Diabetic retinopathy graded by the modified Davis classification.
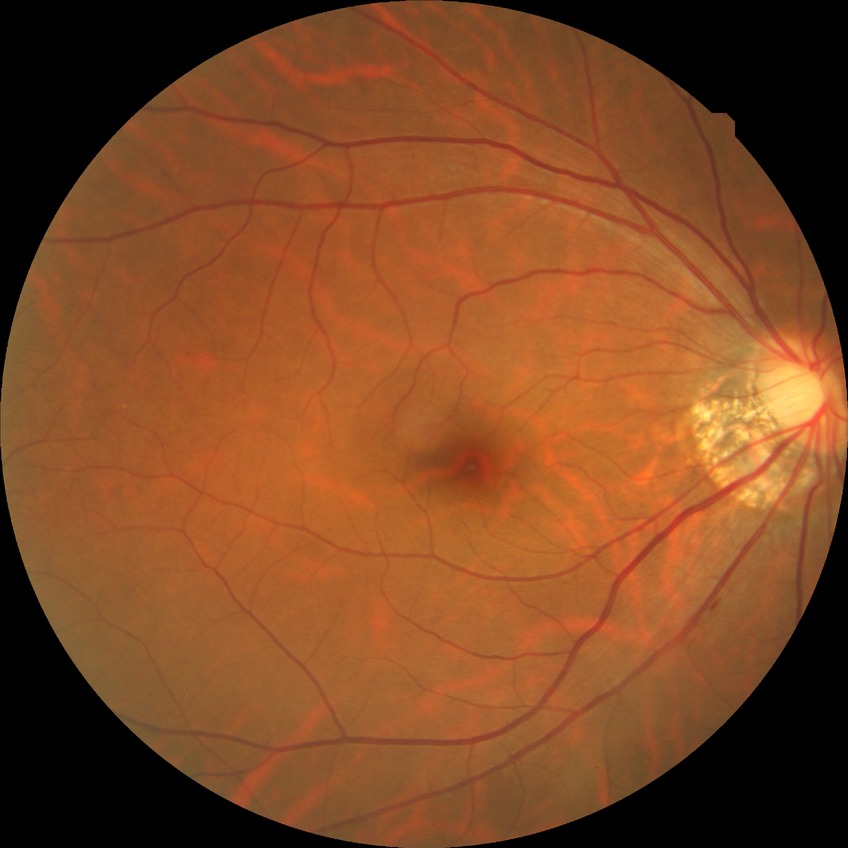

diabetic retinopathy (DR) = NDR (no diabetic retinopathy).